Color fundus image. Image size 1924x1556: 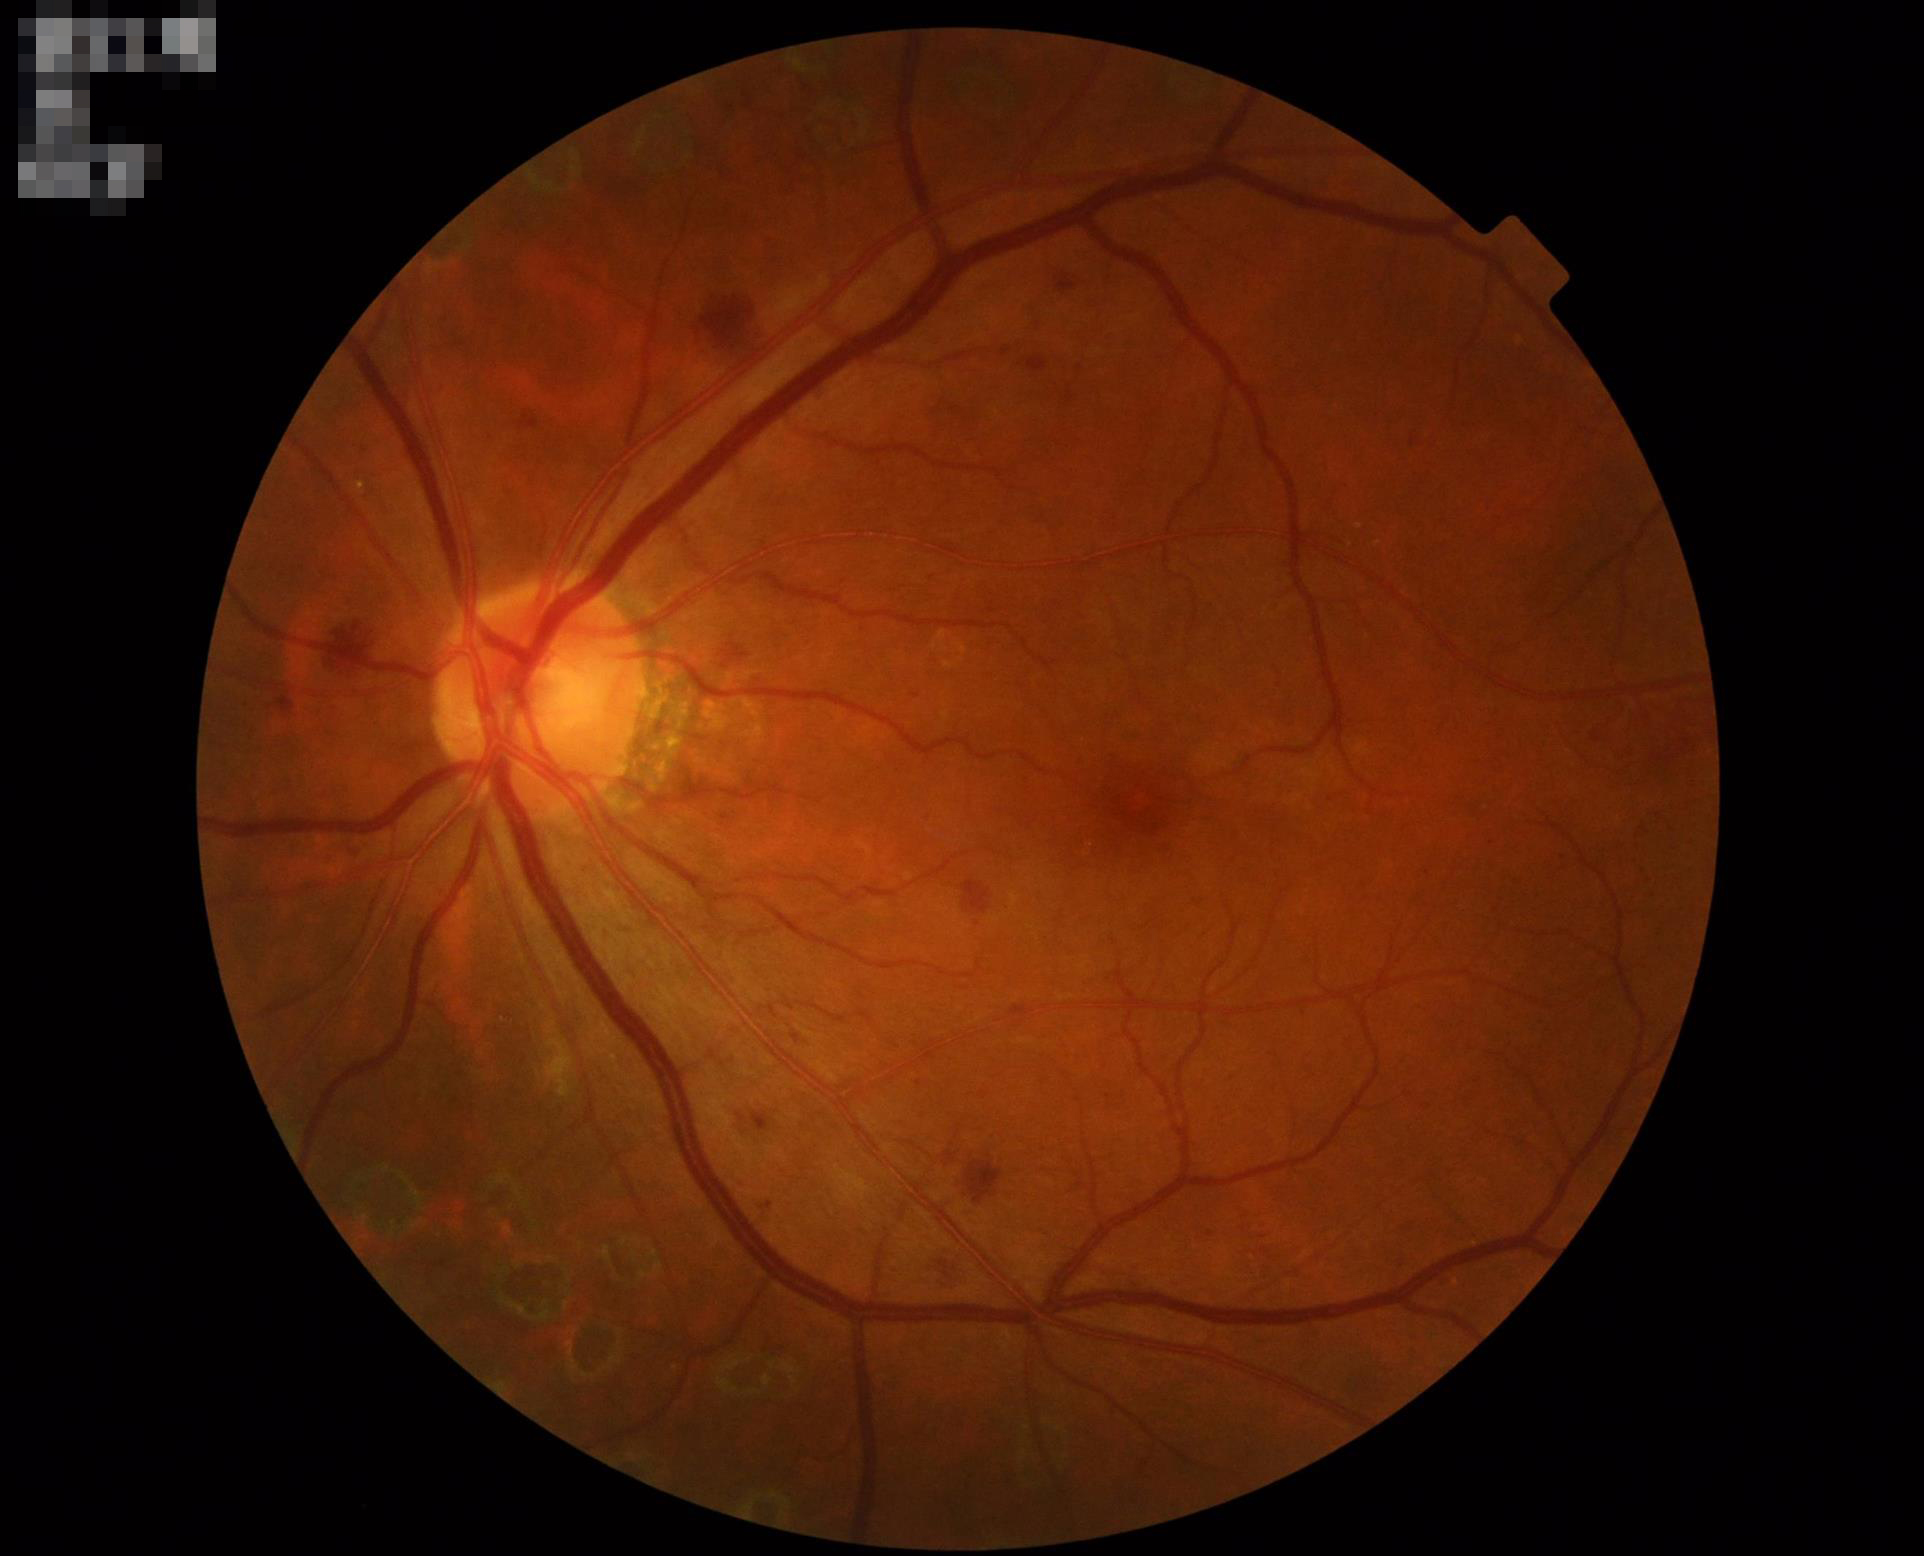
Overall quality is good and the image is gradable. No over- or under-exposure. Contrast is good.